CFP — 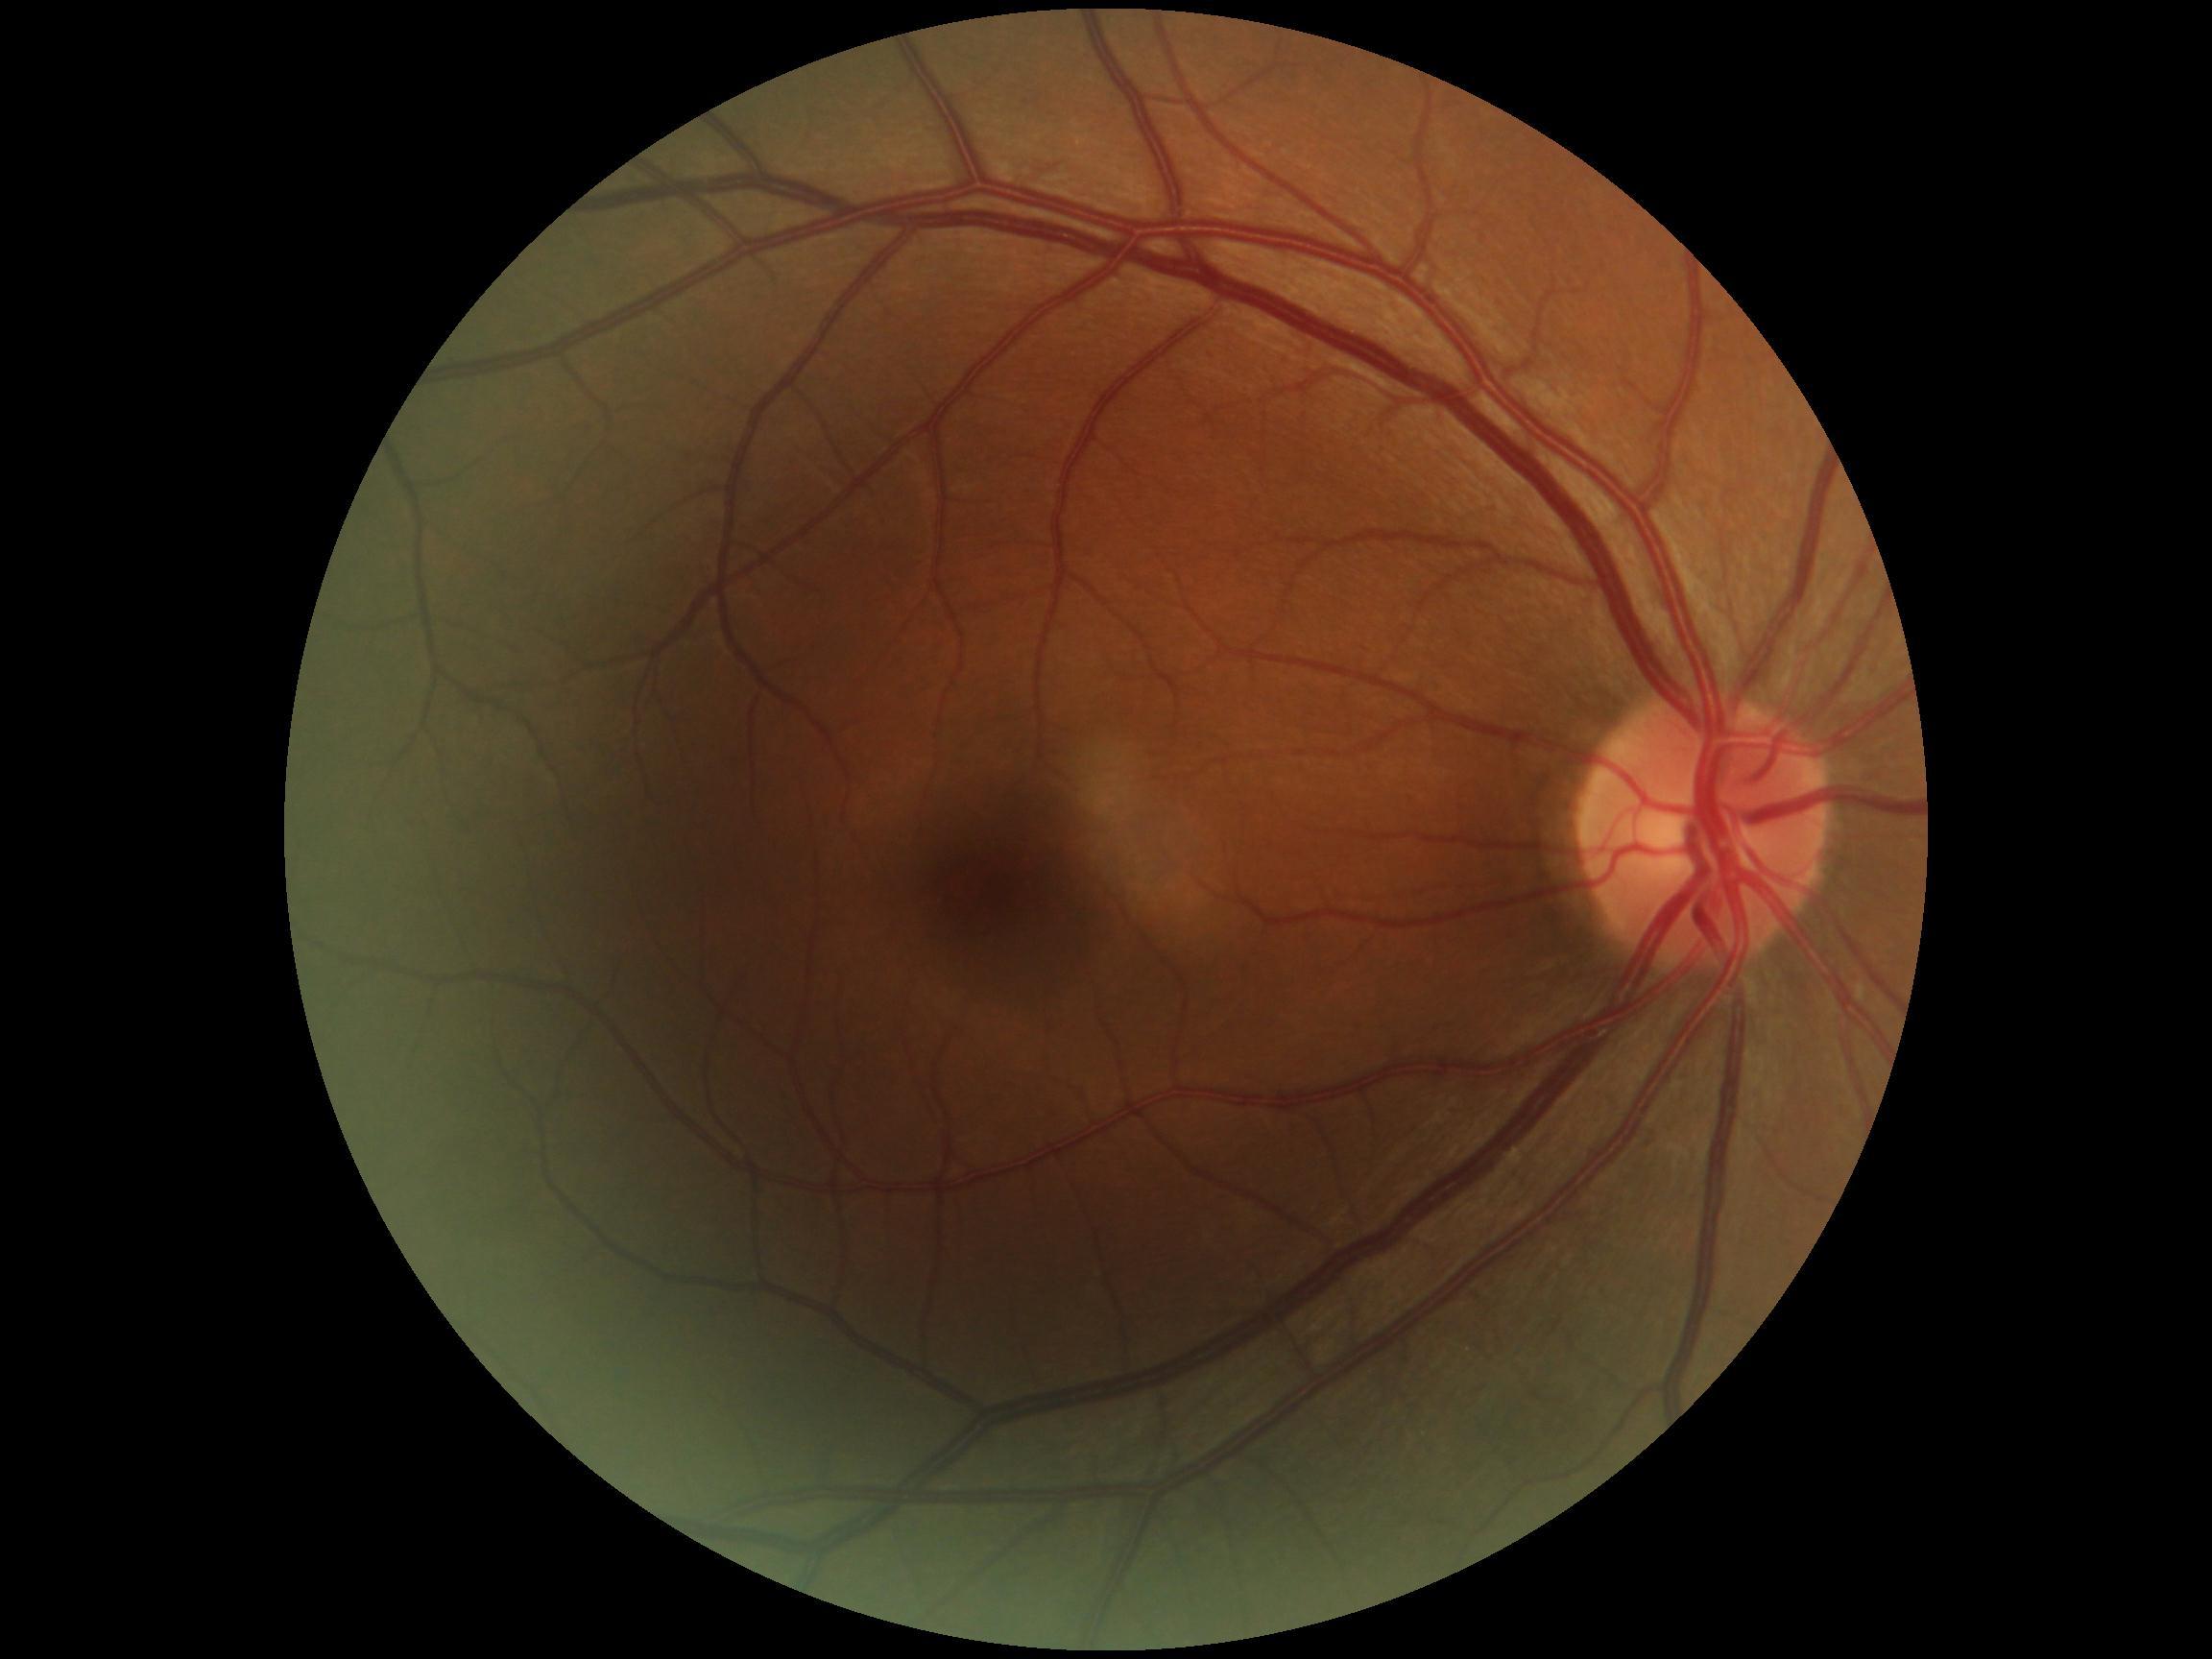 No signs of diabetic retinopathy.
Diabetic retinopathy severity is no apparent diabetic retinopathy (grade 0).